Retinal fundus photograph — 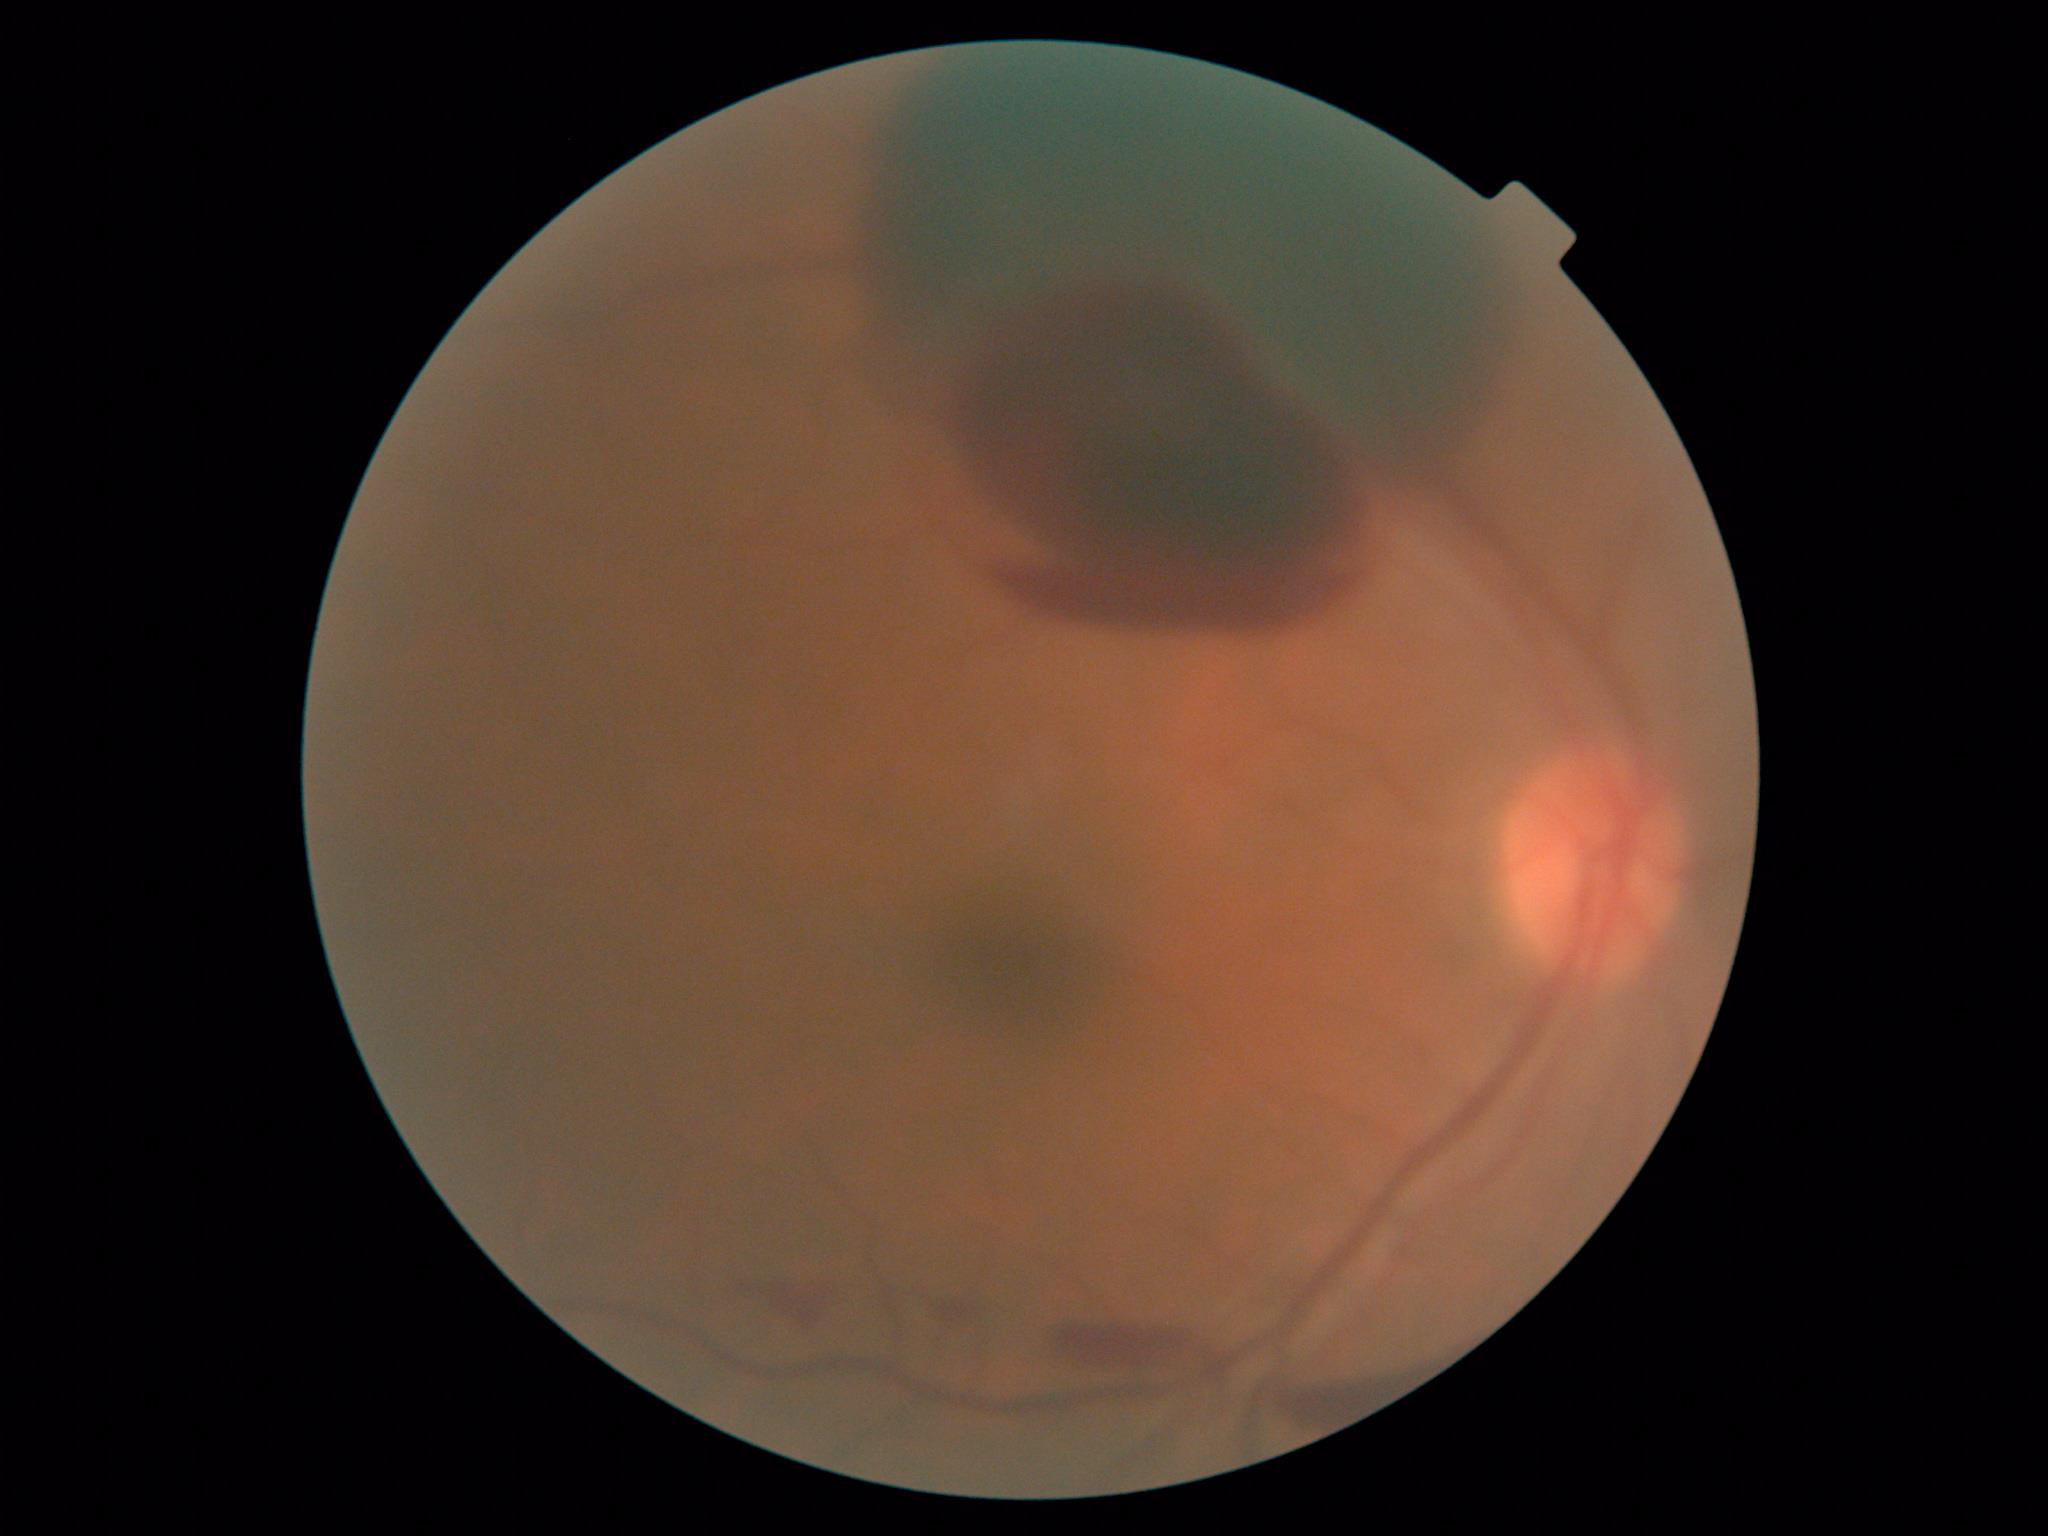 DR class: proliferative diabetic retinopathy. DR severity is 4.